45-degree field of view: 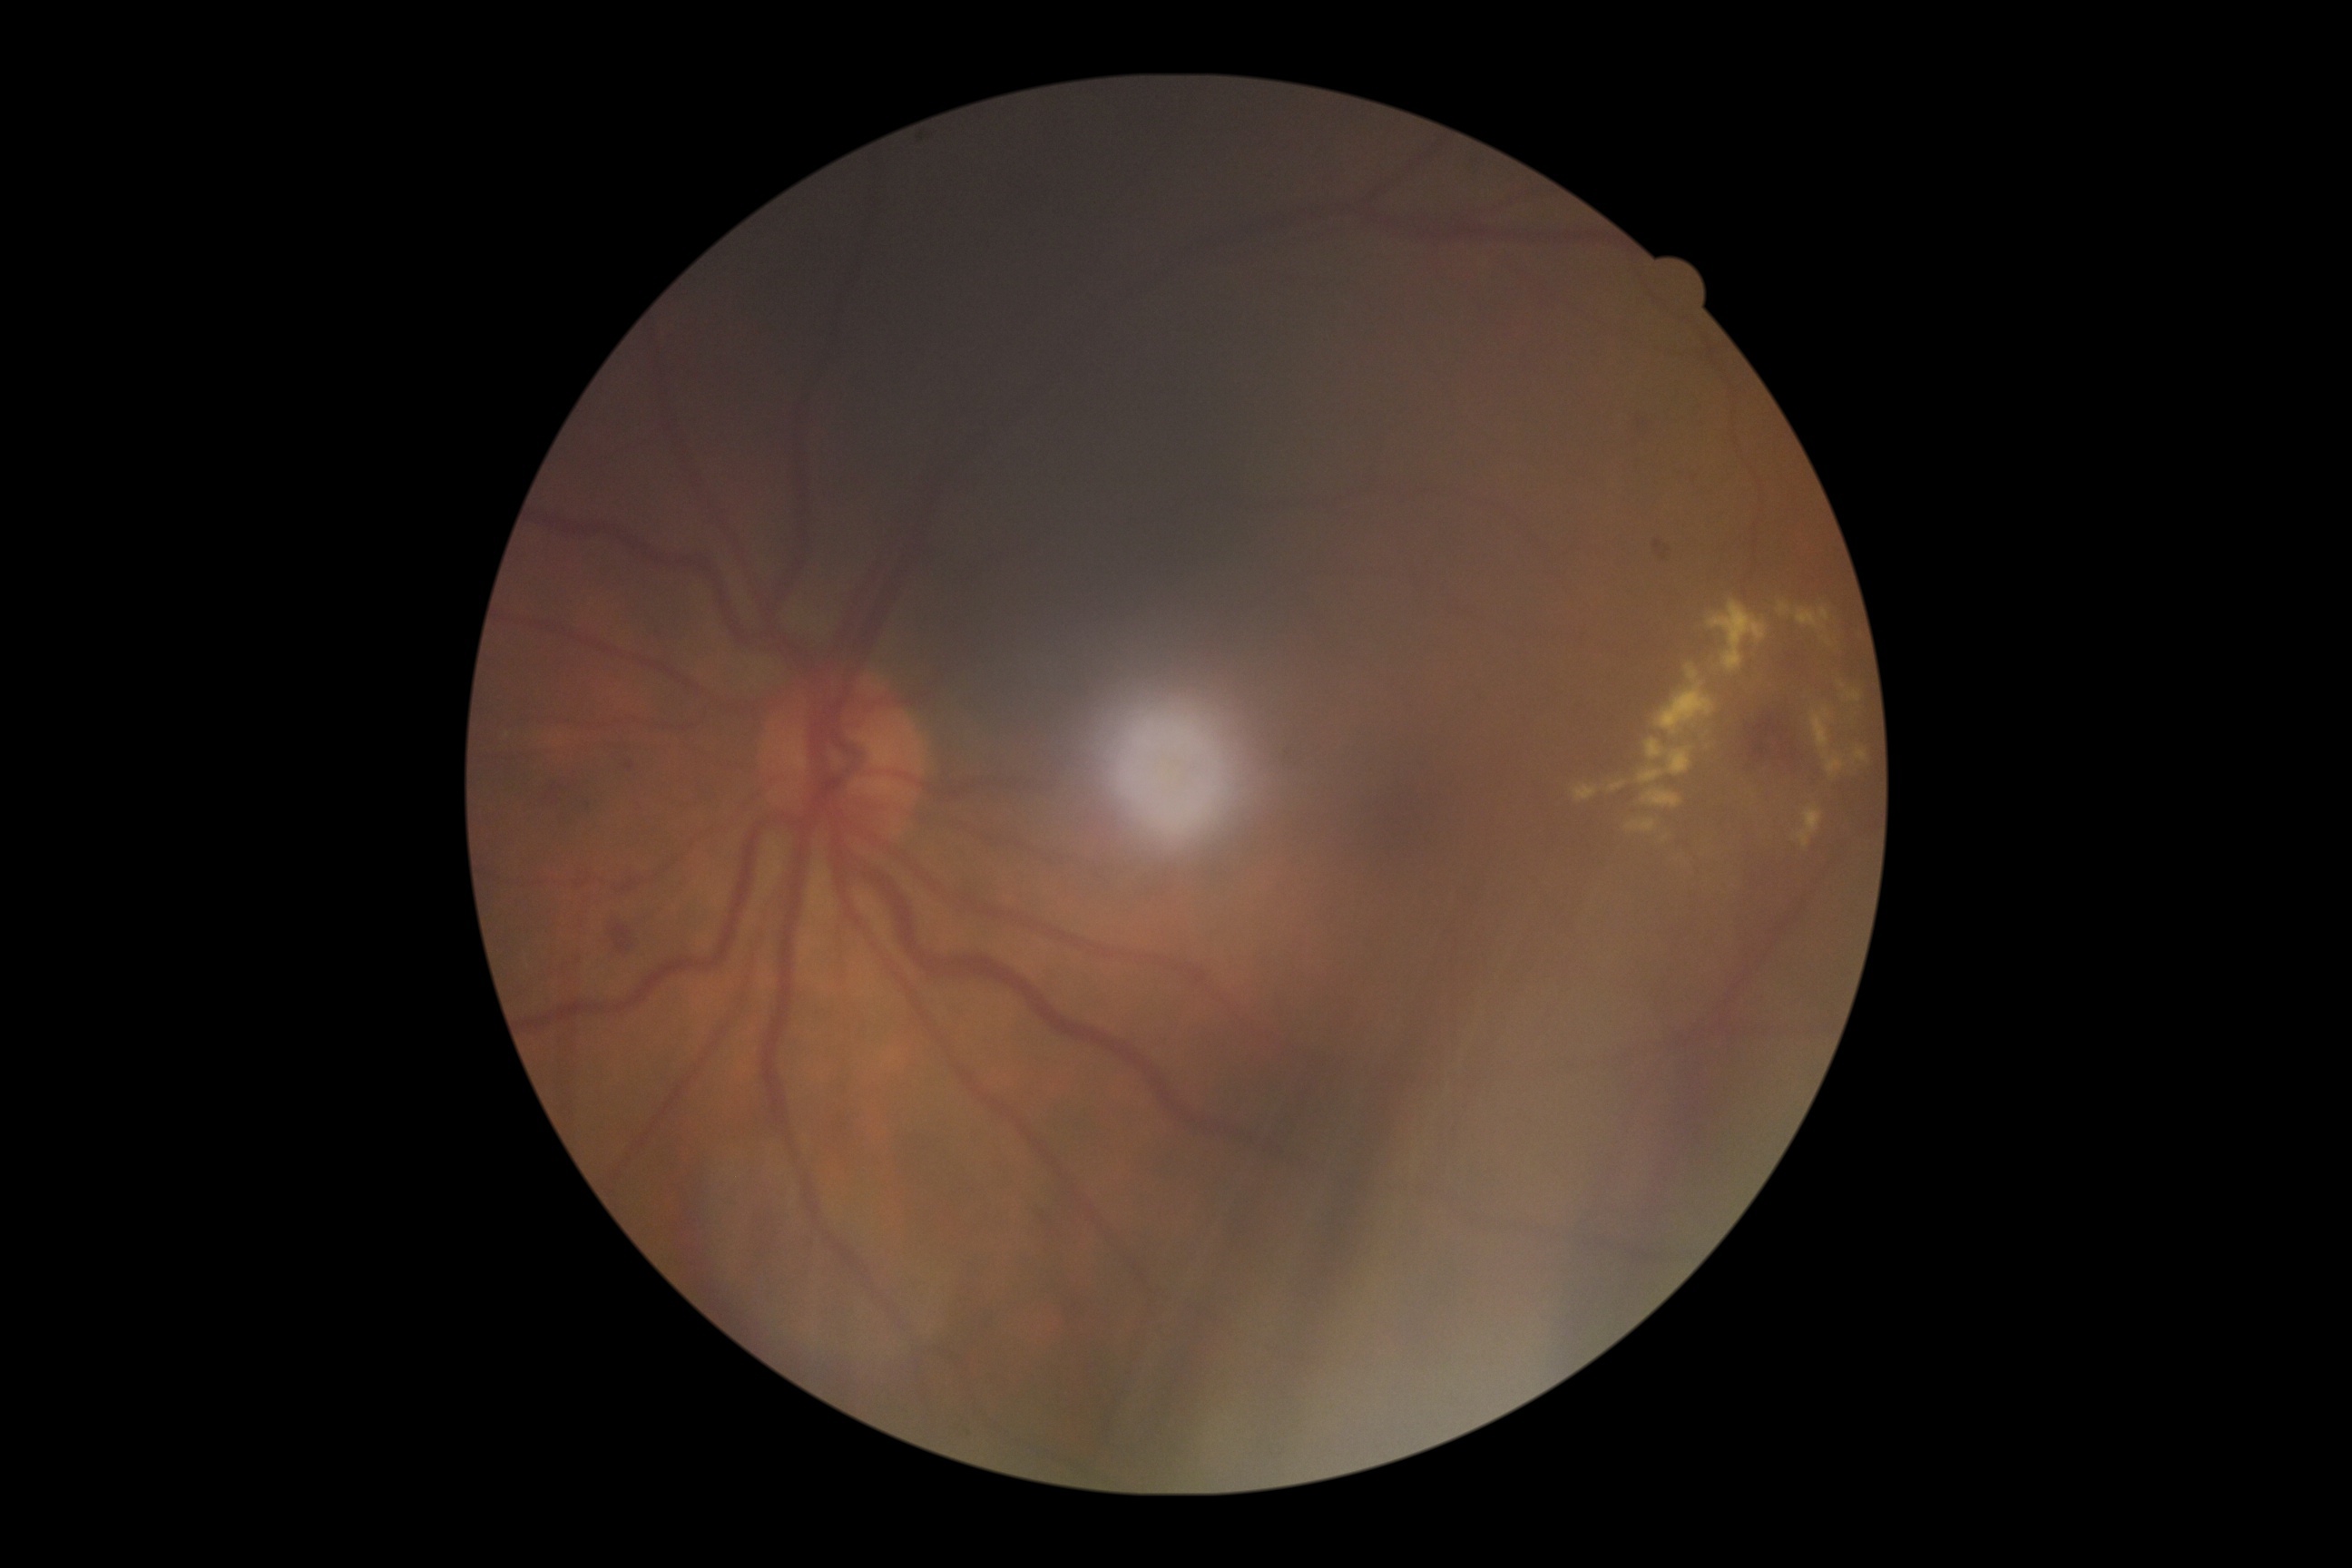
DR stage@grade 2 (moderate NPDR).